Wide-field contact fundus photograph of an infant · 130° field of view (Clarity RetCam 3).
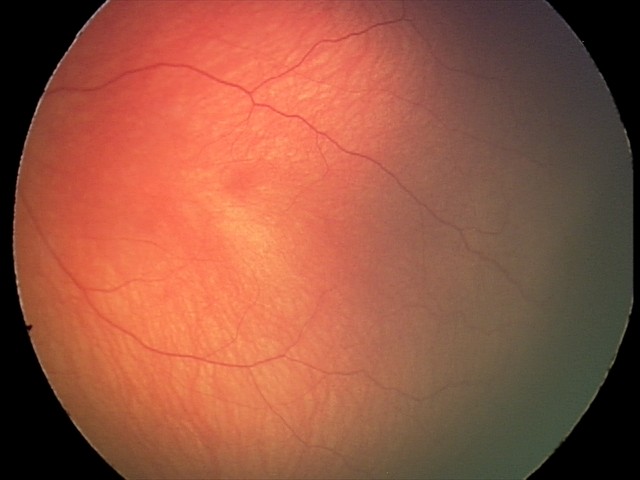

Examination diagnosed as retinal hemorrhages.